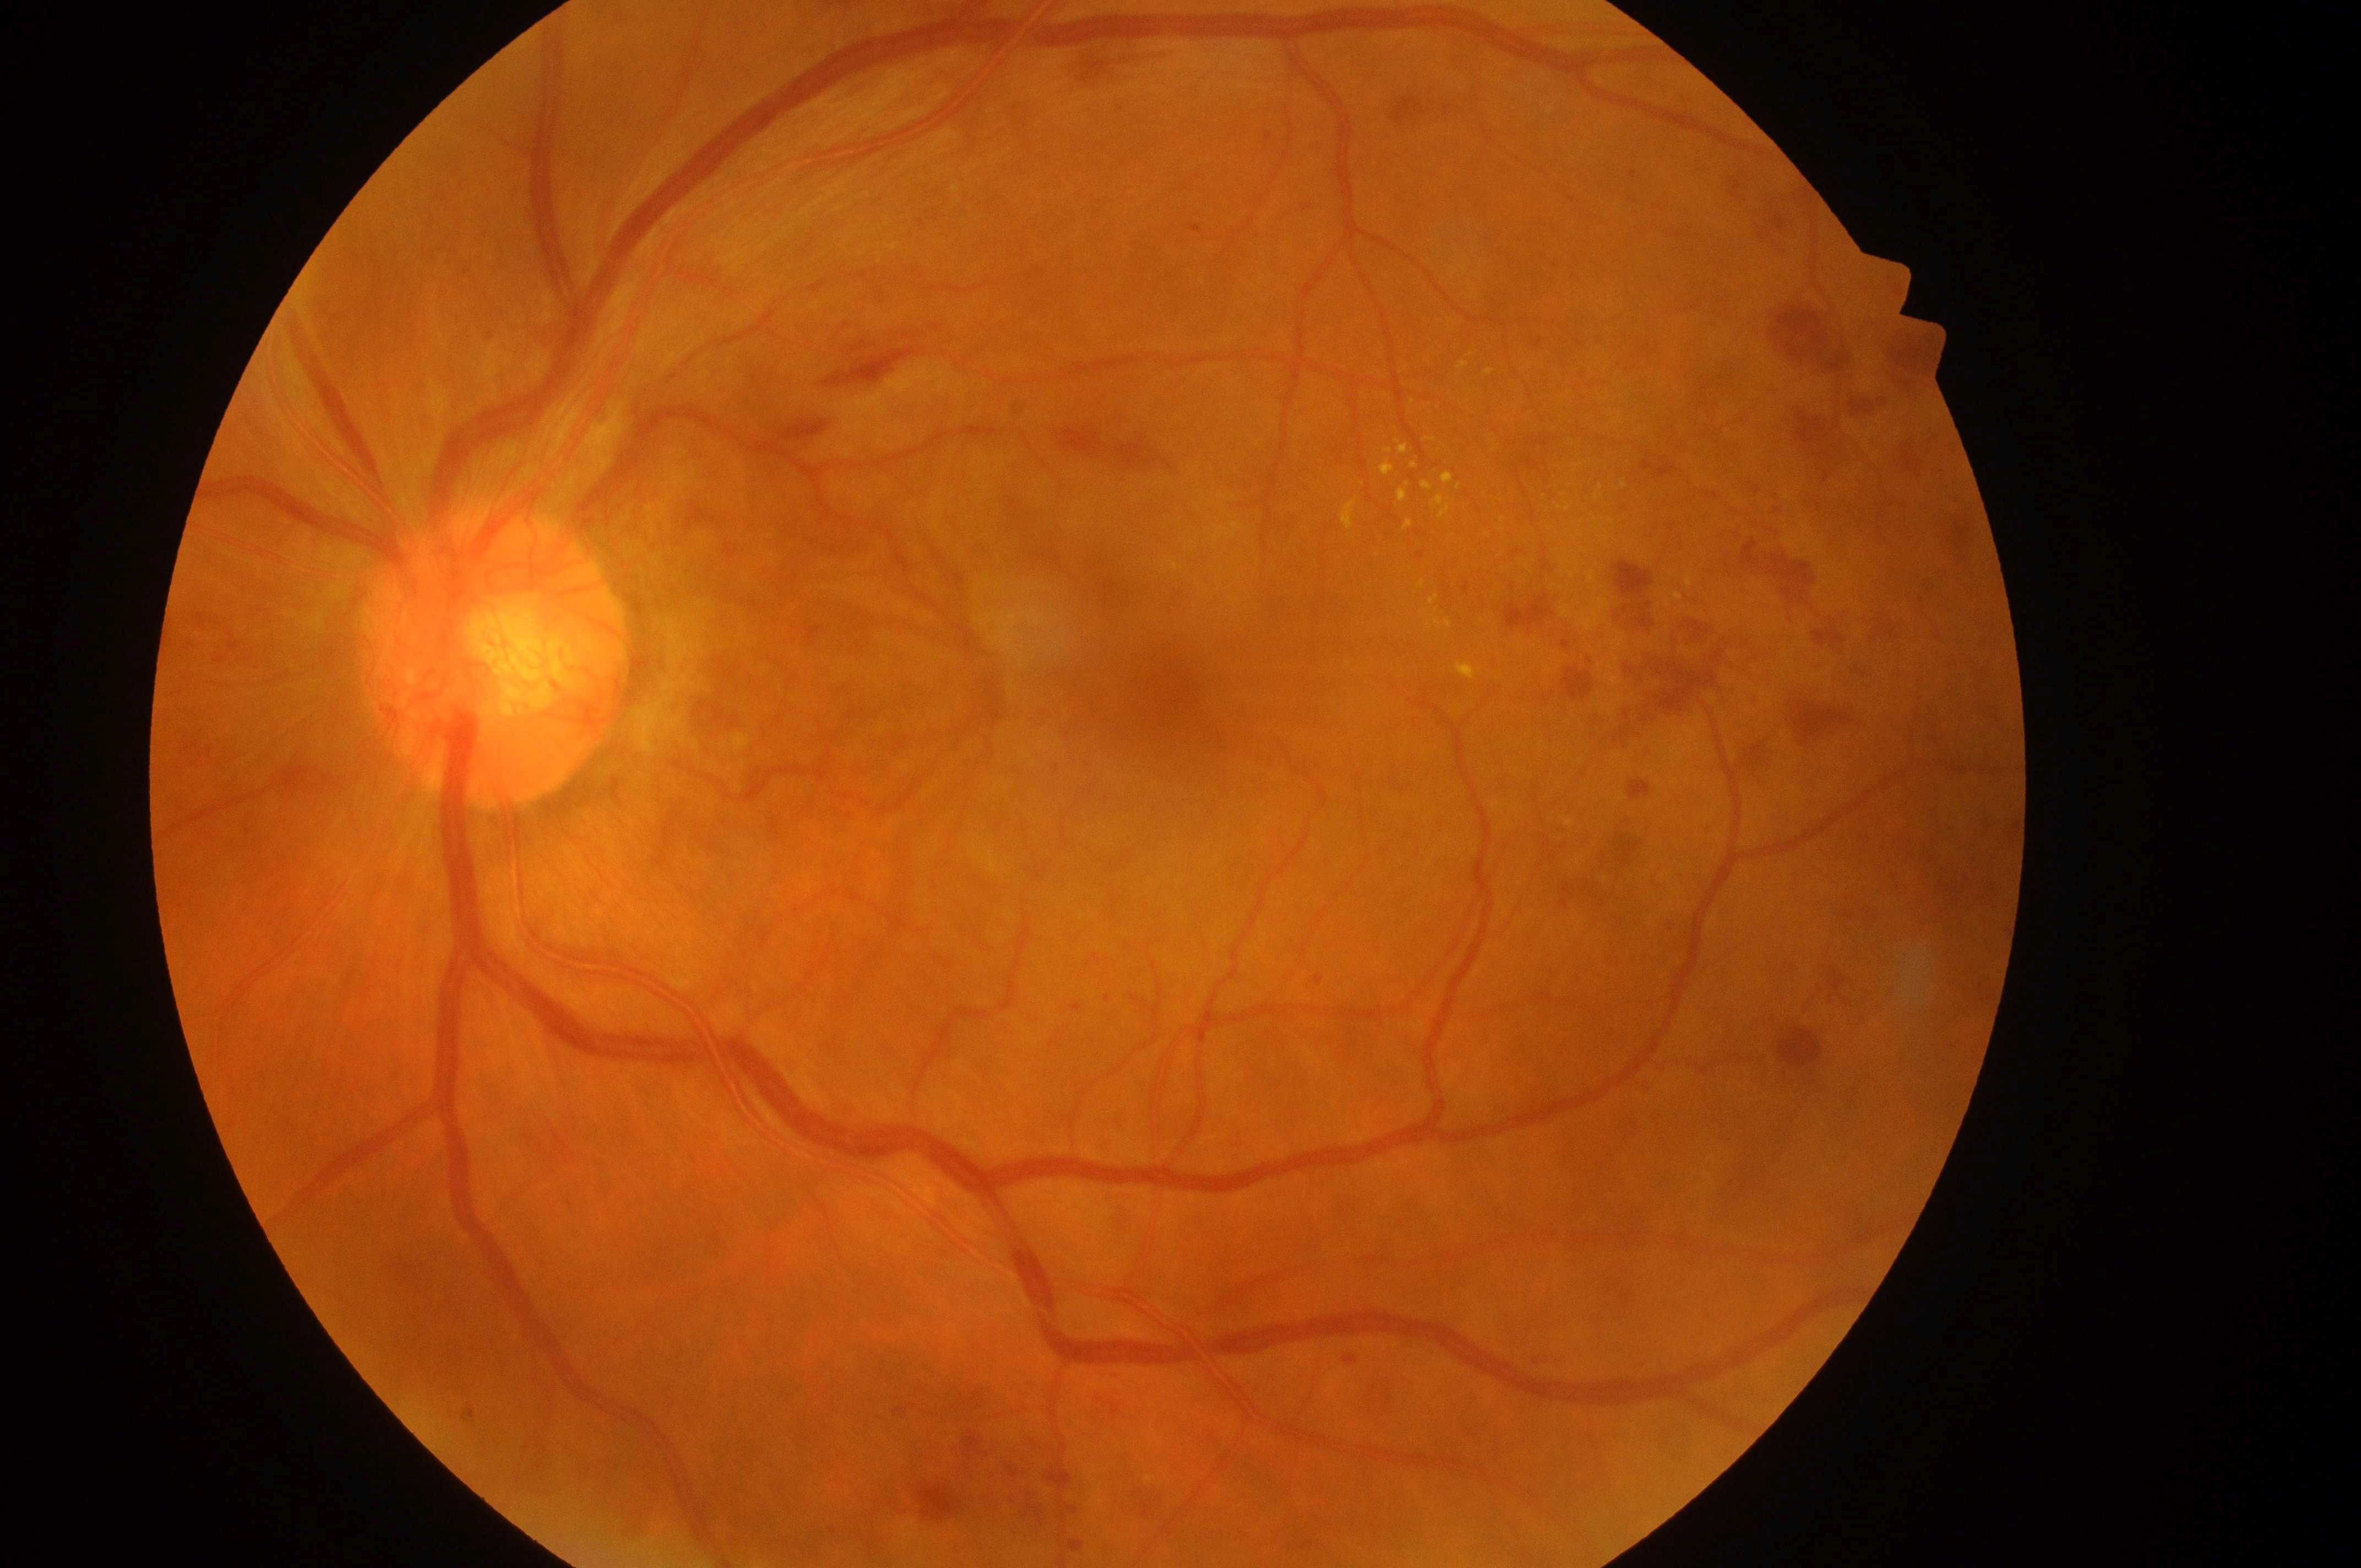 The image shows the OS. Fovea: (1184, 693). Risk of diabetic macular edema: high risk (grade 2). Diabetic retinopathy severity is PDR (grade 4). Optic disc center located at (487, 660).